Pediatric retinal photograph (wide-field)
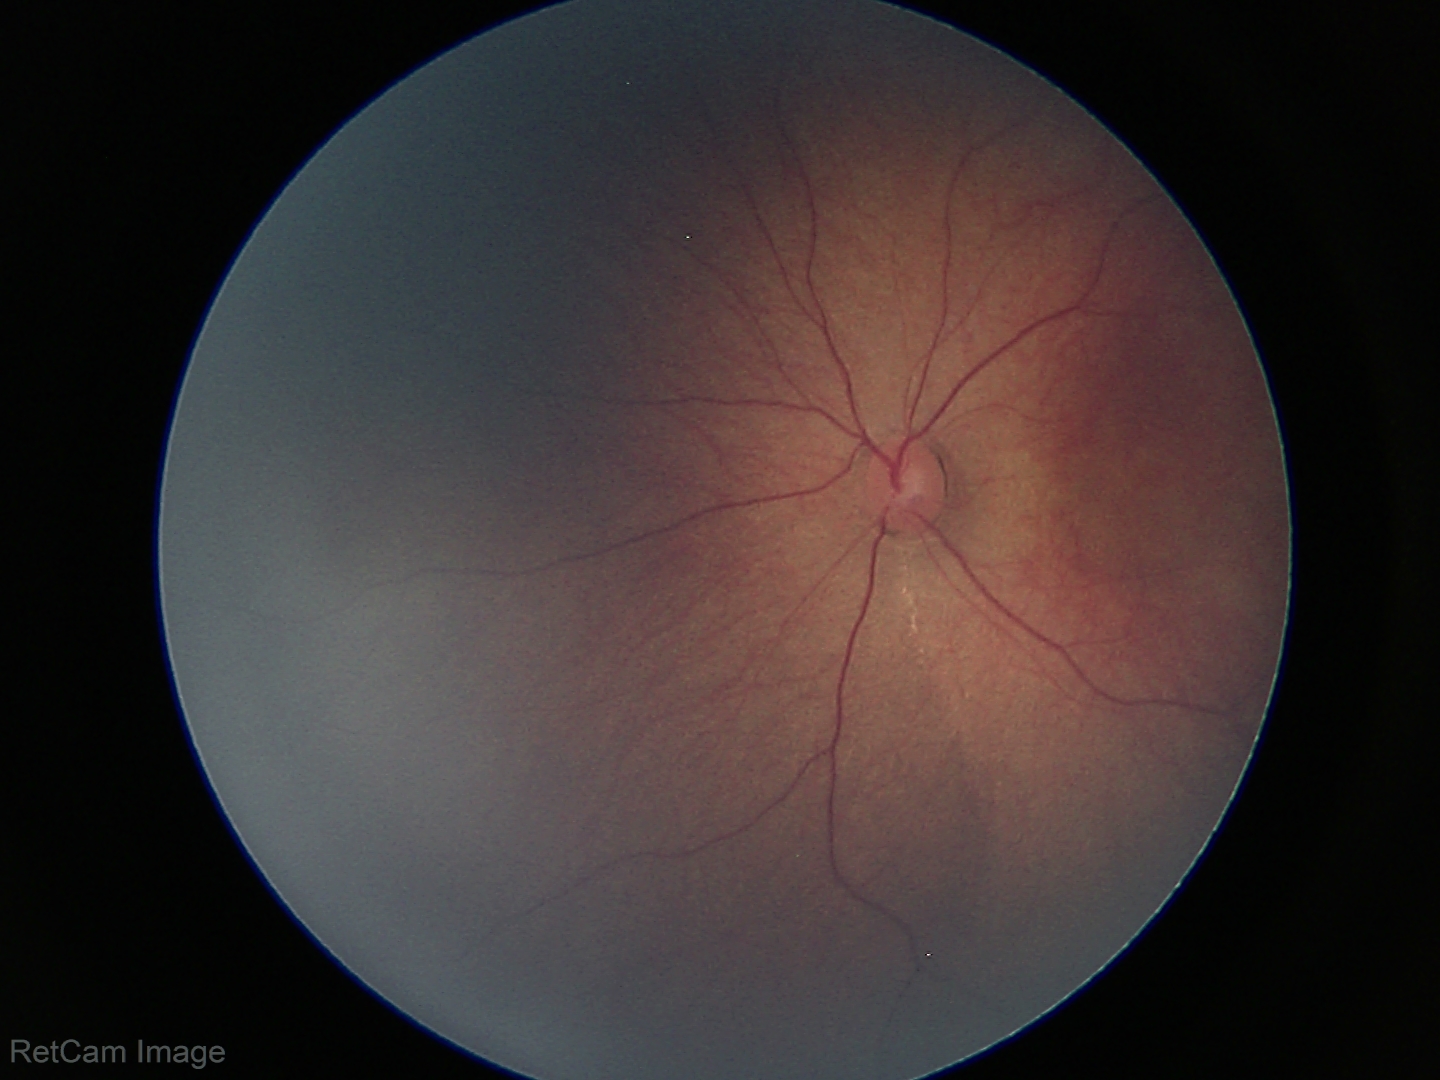
No retinal pathology identified on screening.